640x480px. Infant wide-field retinal image:
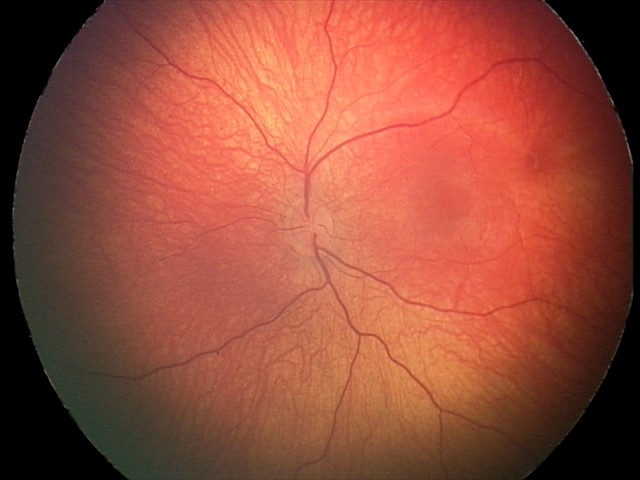

Examination diagnosed as retinal hemorrhages.